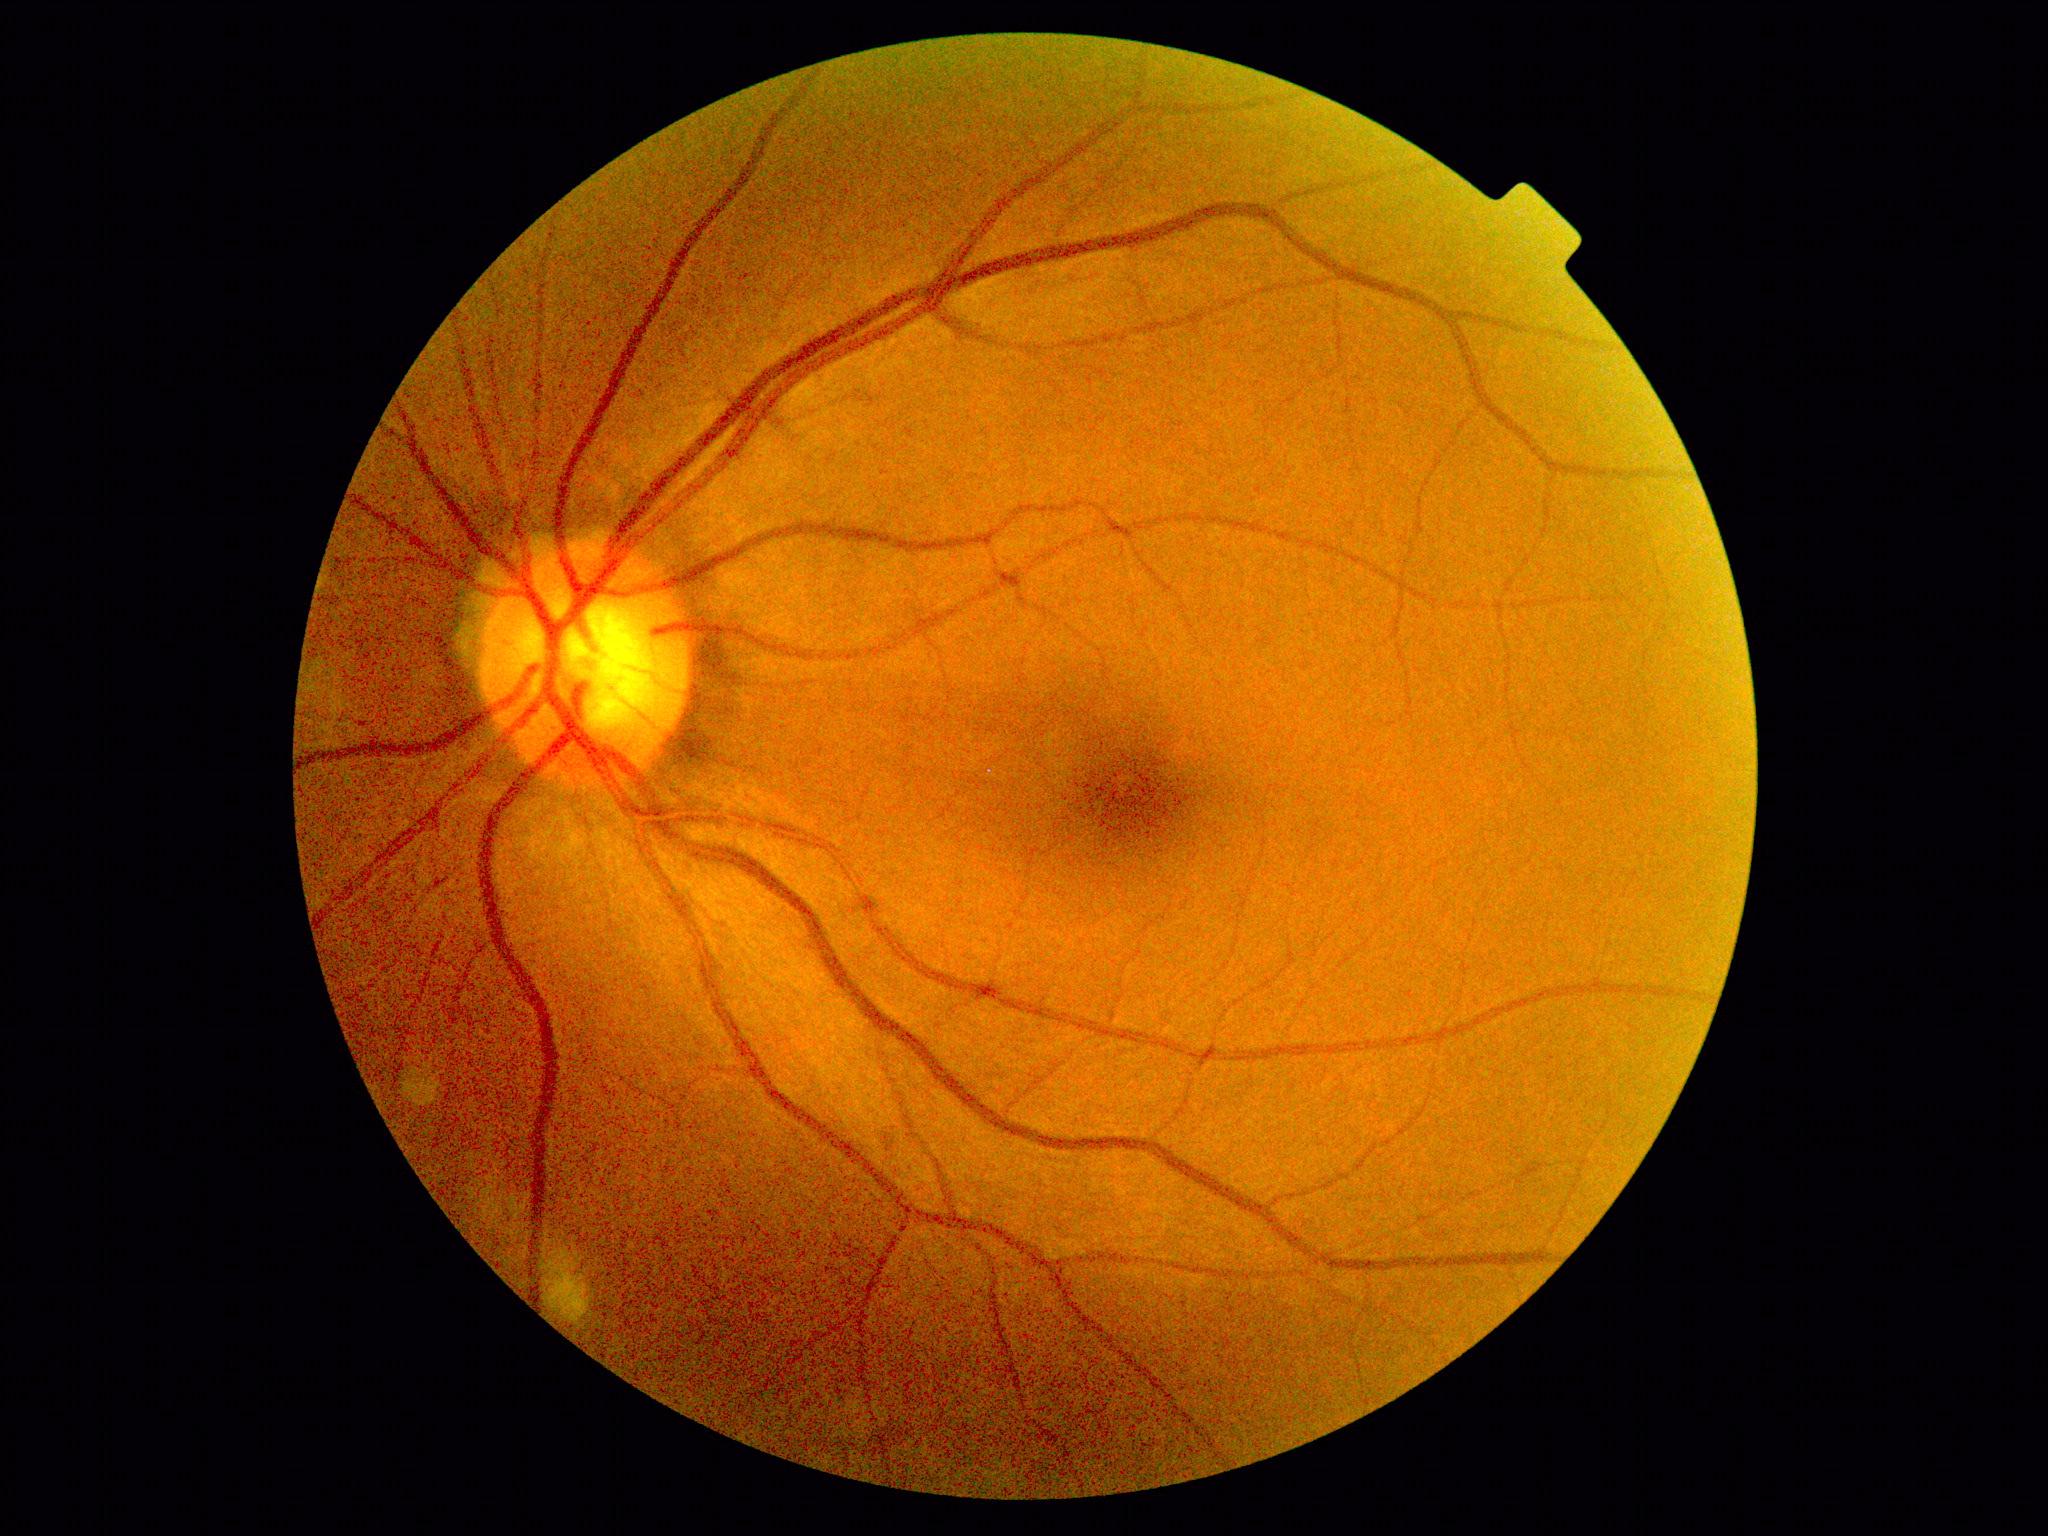

diabetic retinopathy severity: grade 0.